2212 by 1659 pixels — 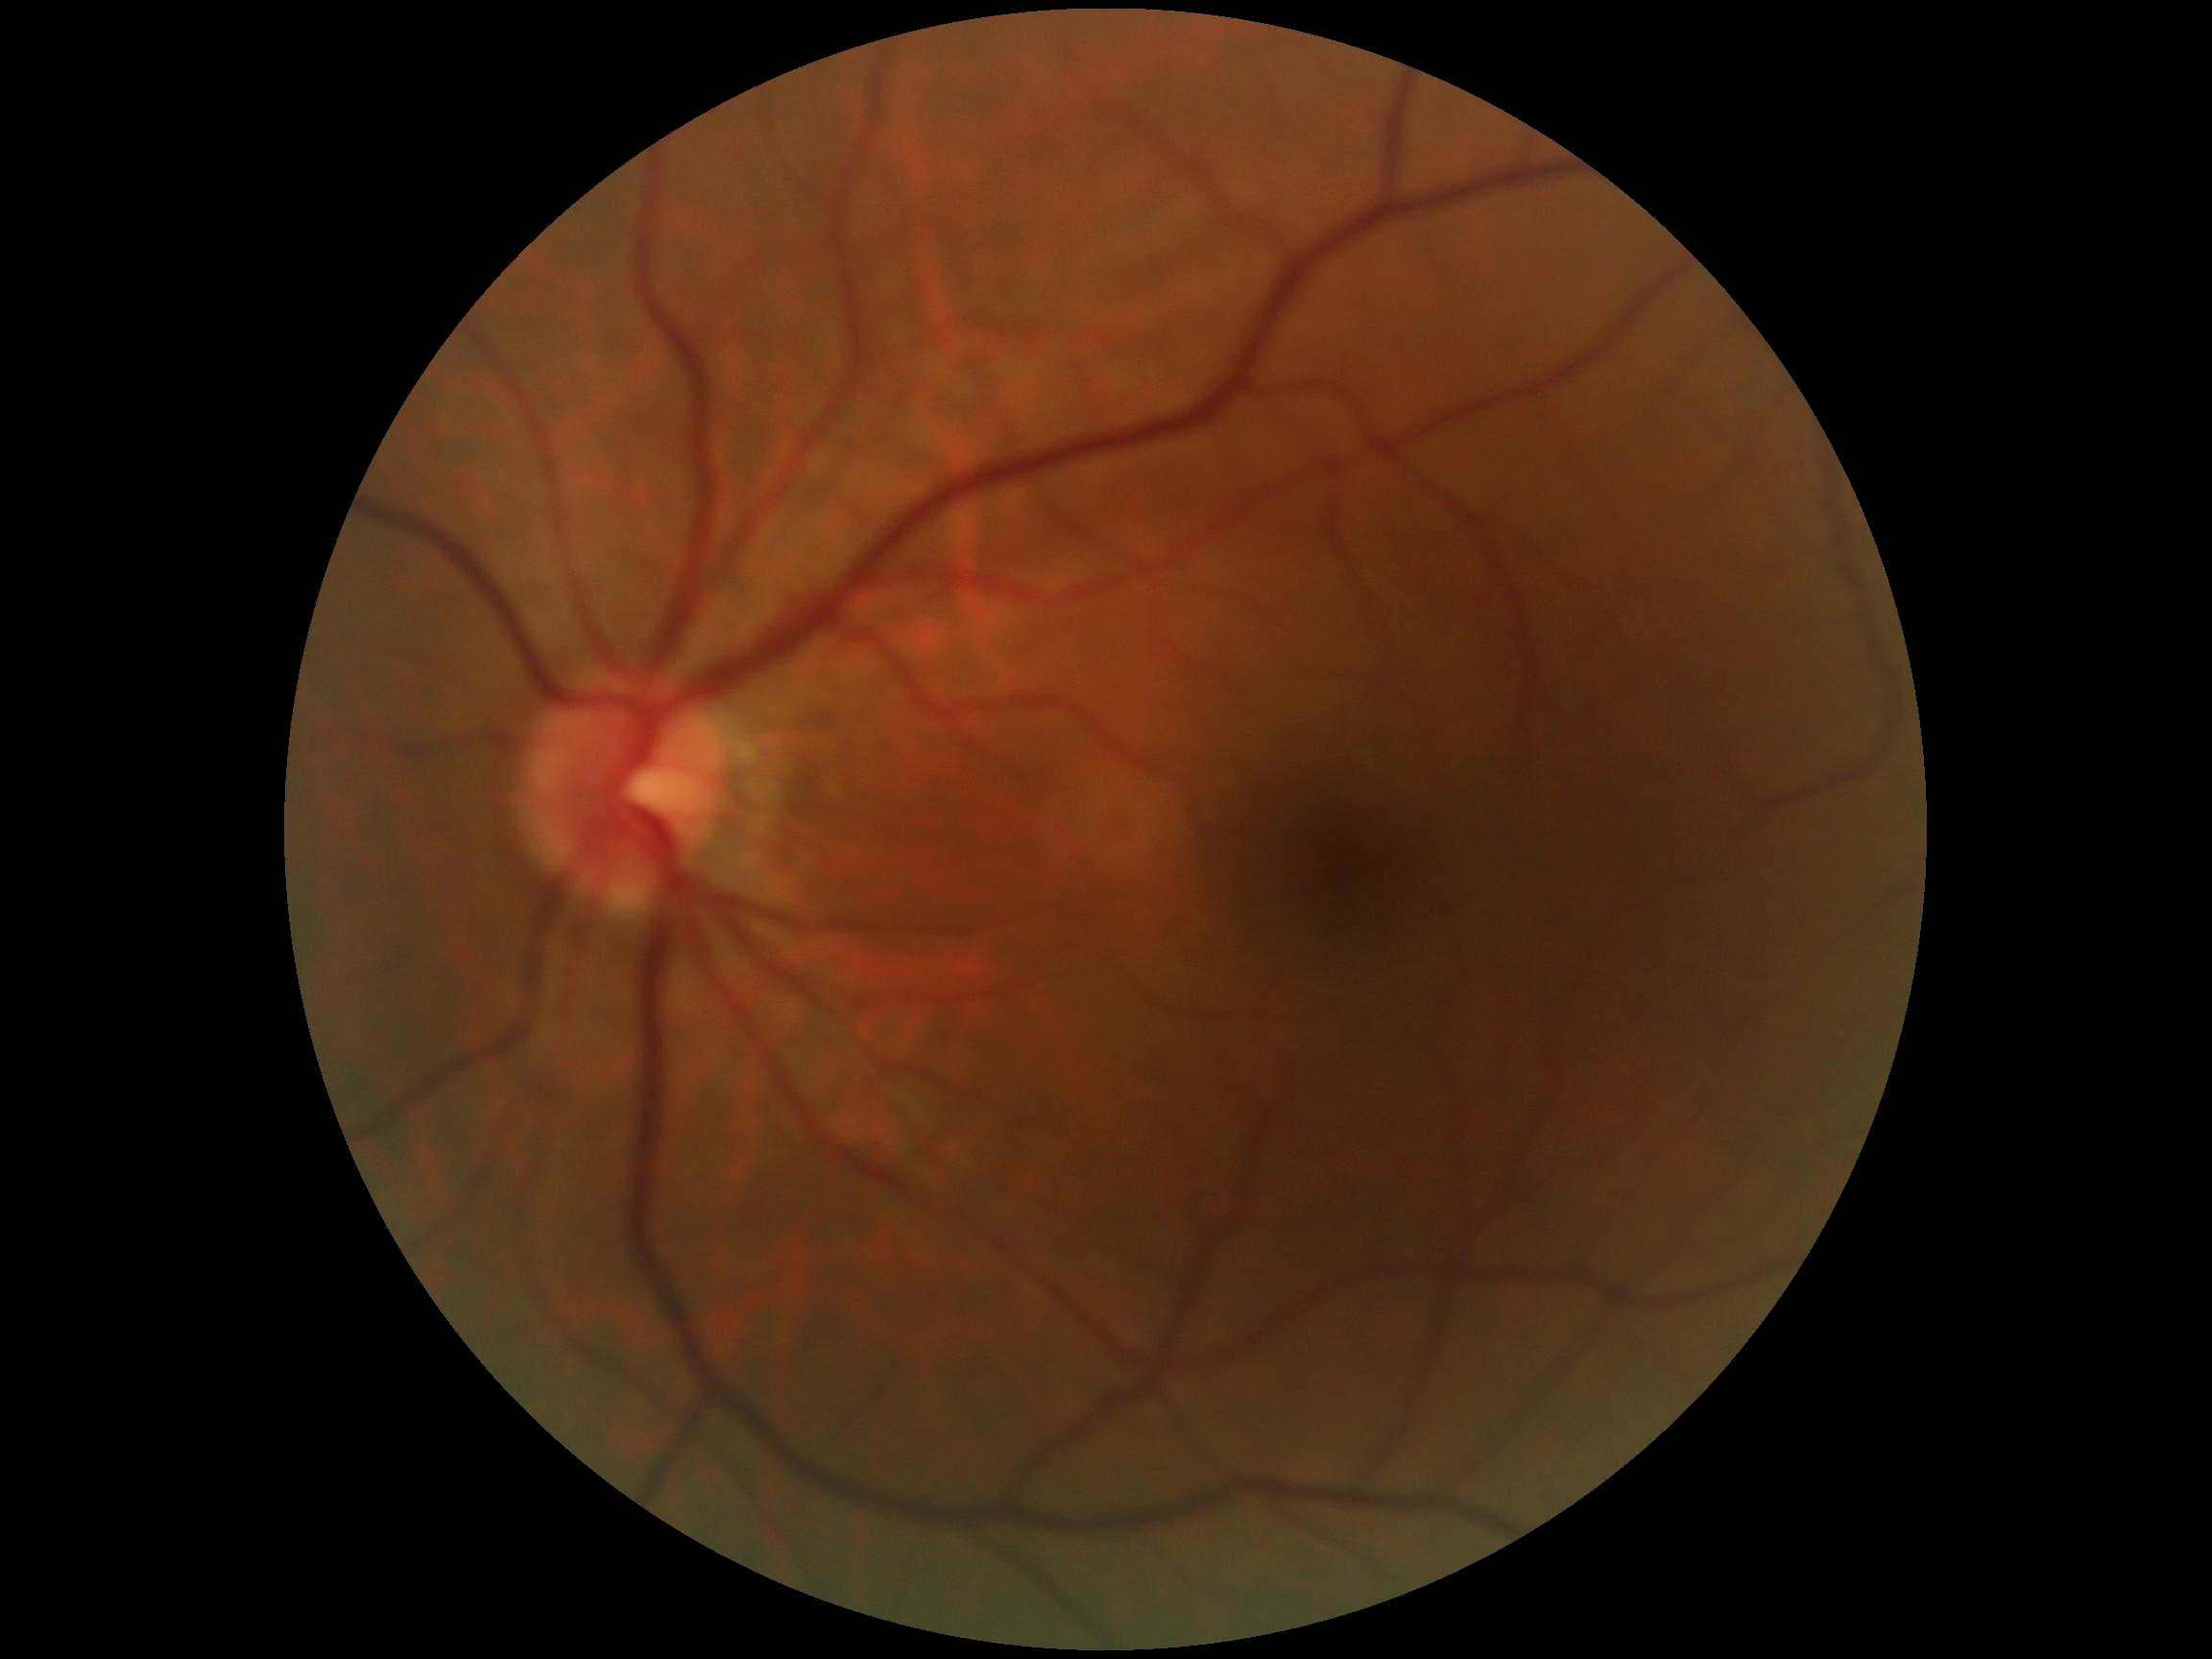   dr_impression: no signs of DR
  dr_grade: 0 (no apparent retinopathy)